848 by 848 pixels · 45° field of view · acquired with a NIDEK AFC-230:
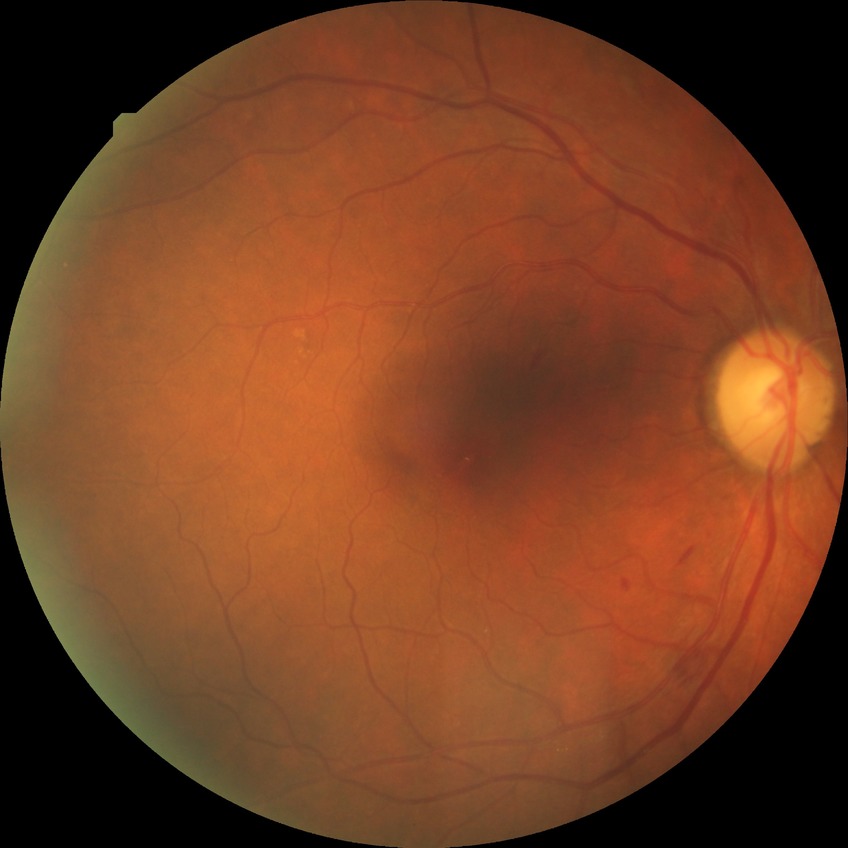 Disease class: non-proliferative diabetic retinopathy. Diabetic retinopathy (DR) is SDR (simple diabetic retinopathy).